2228 x 1652 pixels; captured on a Topcon TRC-50DX fundus camera; 50-degree field of view; posterior pole field covering the optic disc and macula — 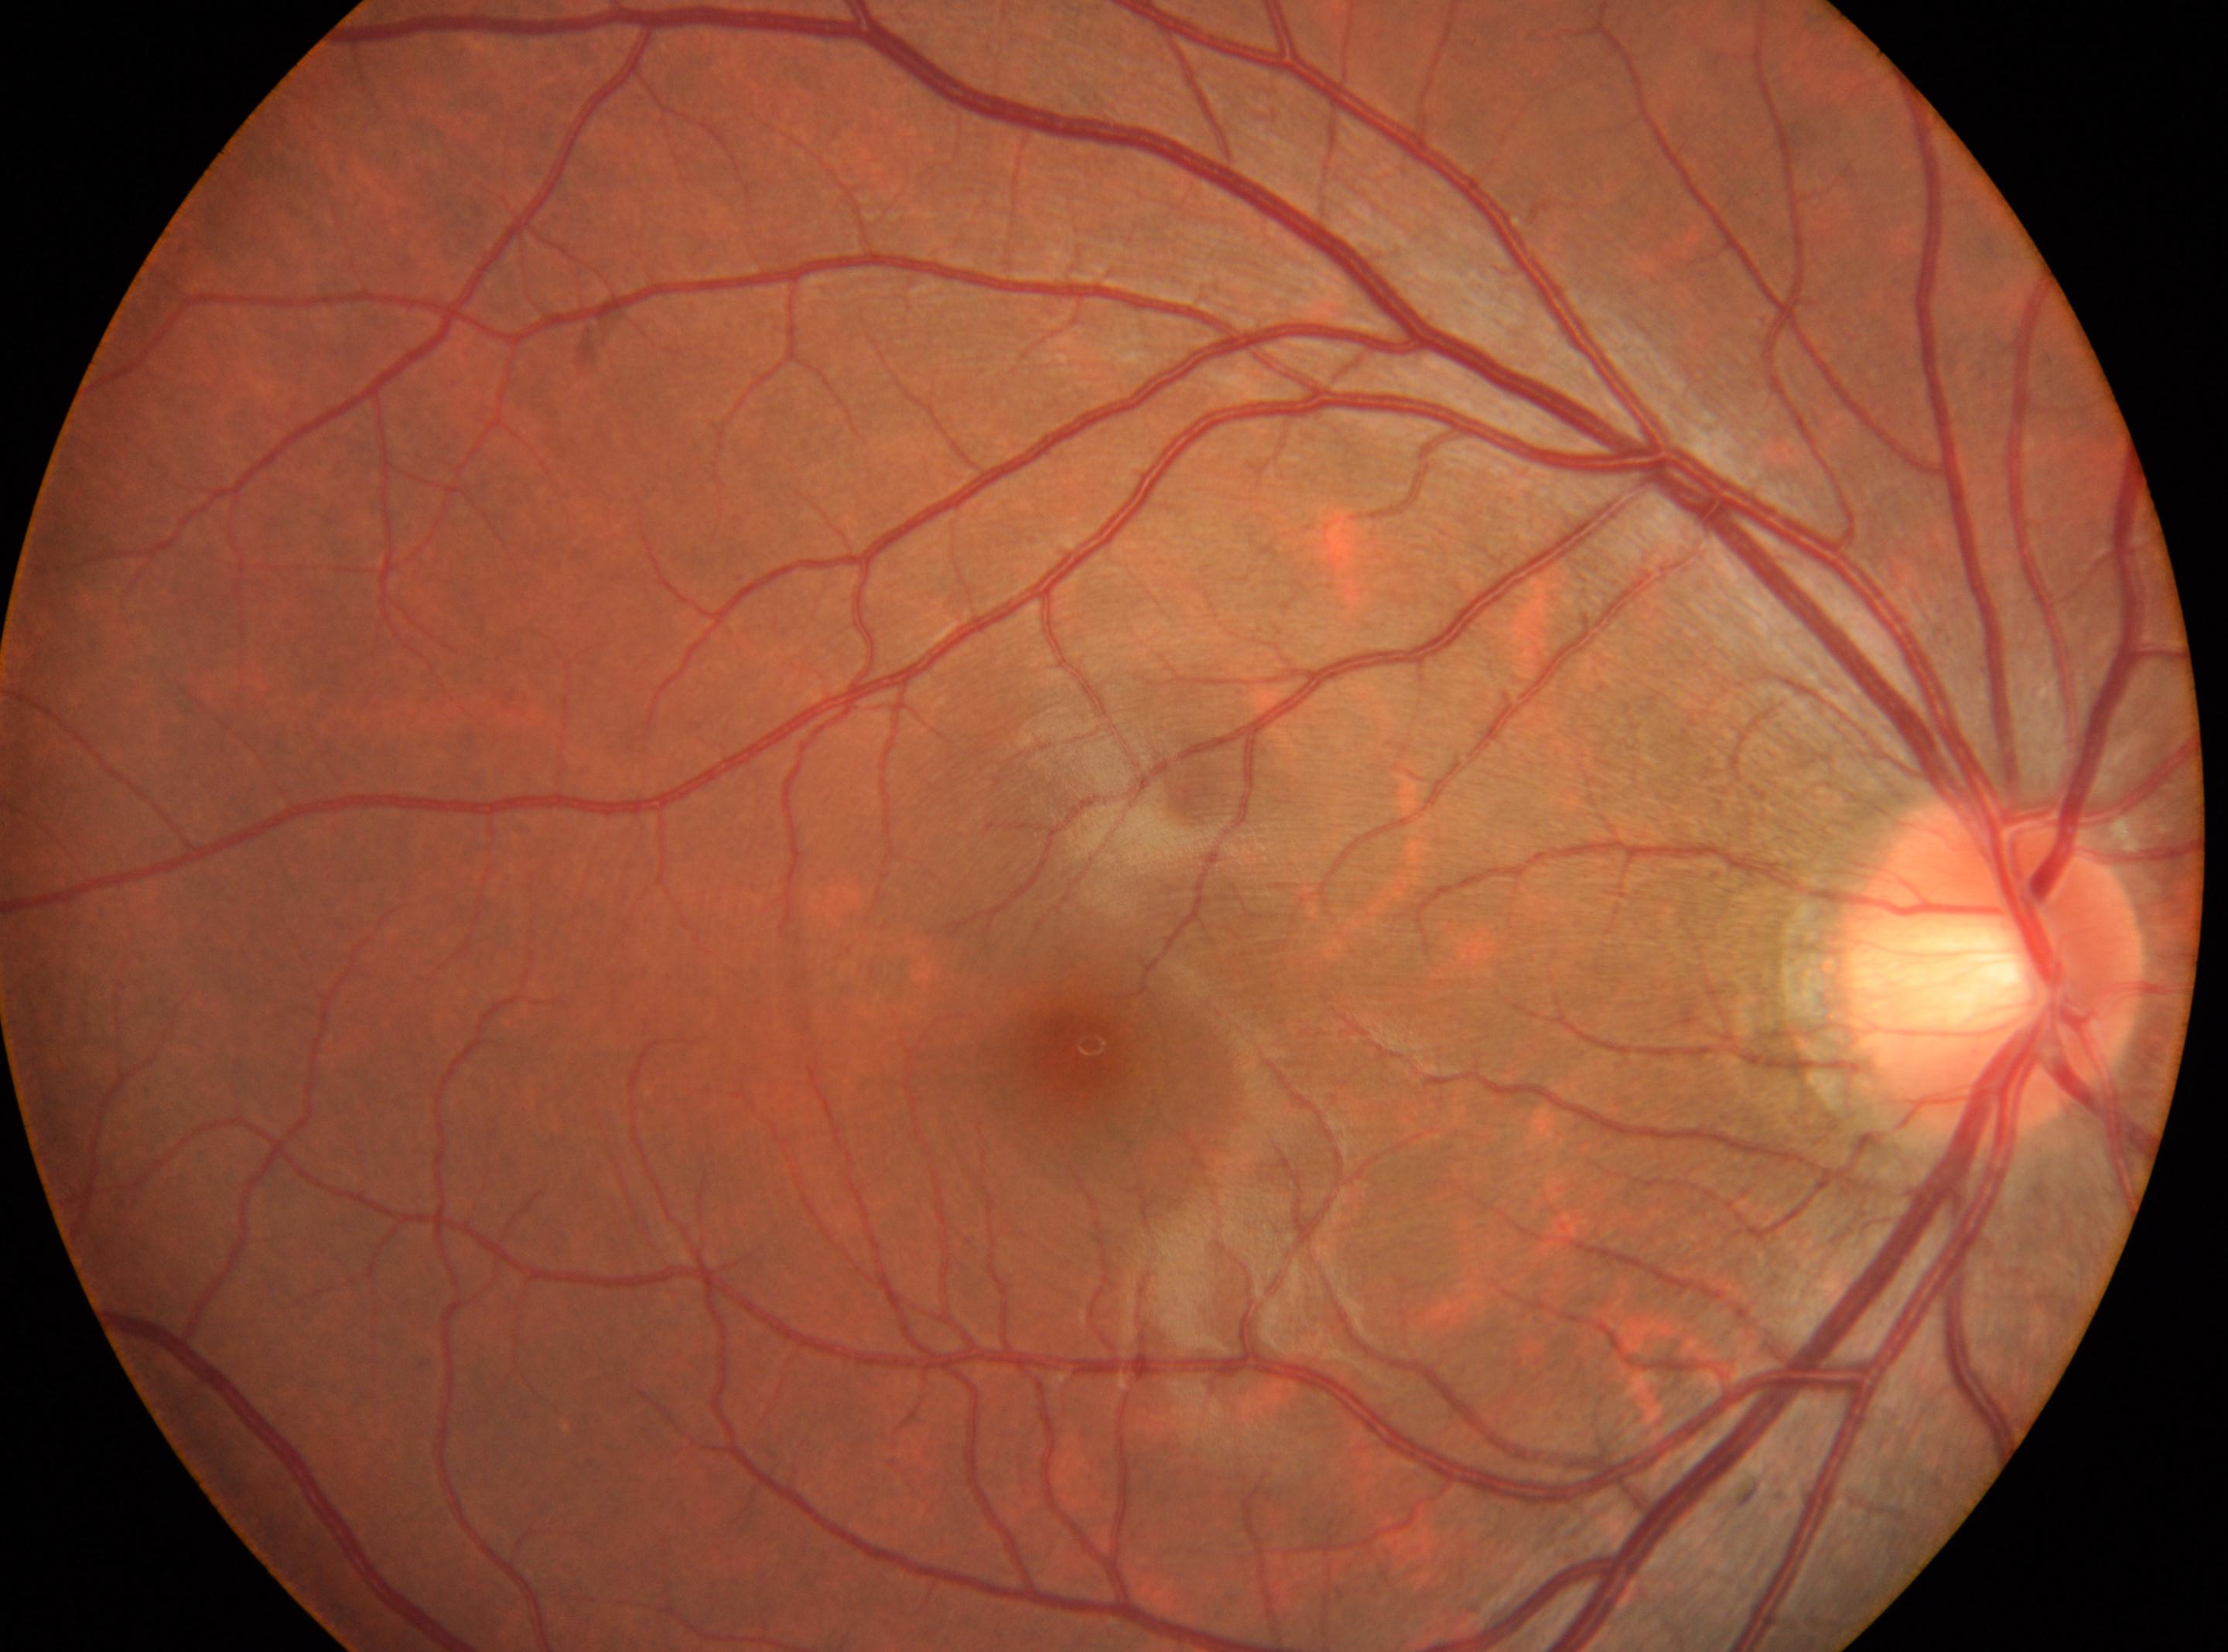
Optic disc center: [1990, 966].
Fovea center located at [1086, 1052].
Diabetic retinopathy grade is 0/4.
Imaged eye: OD.